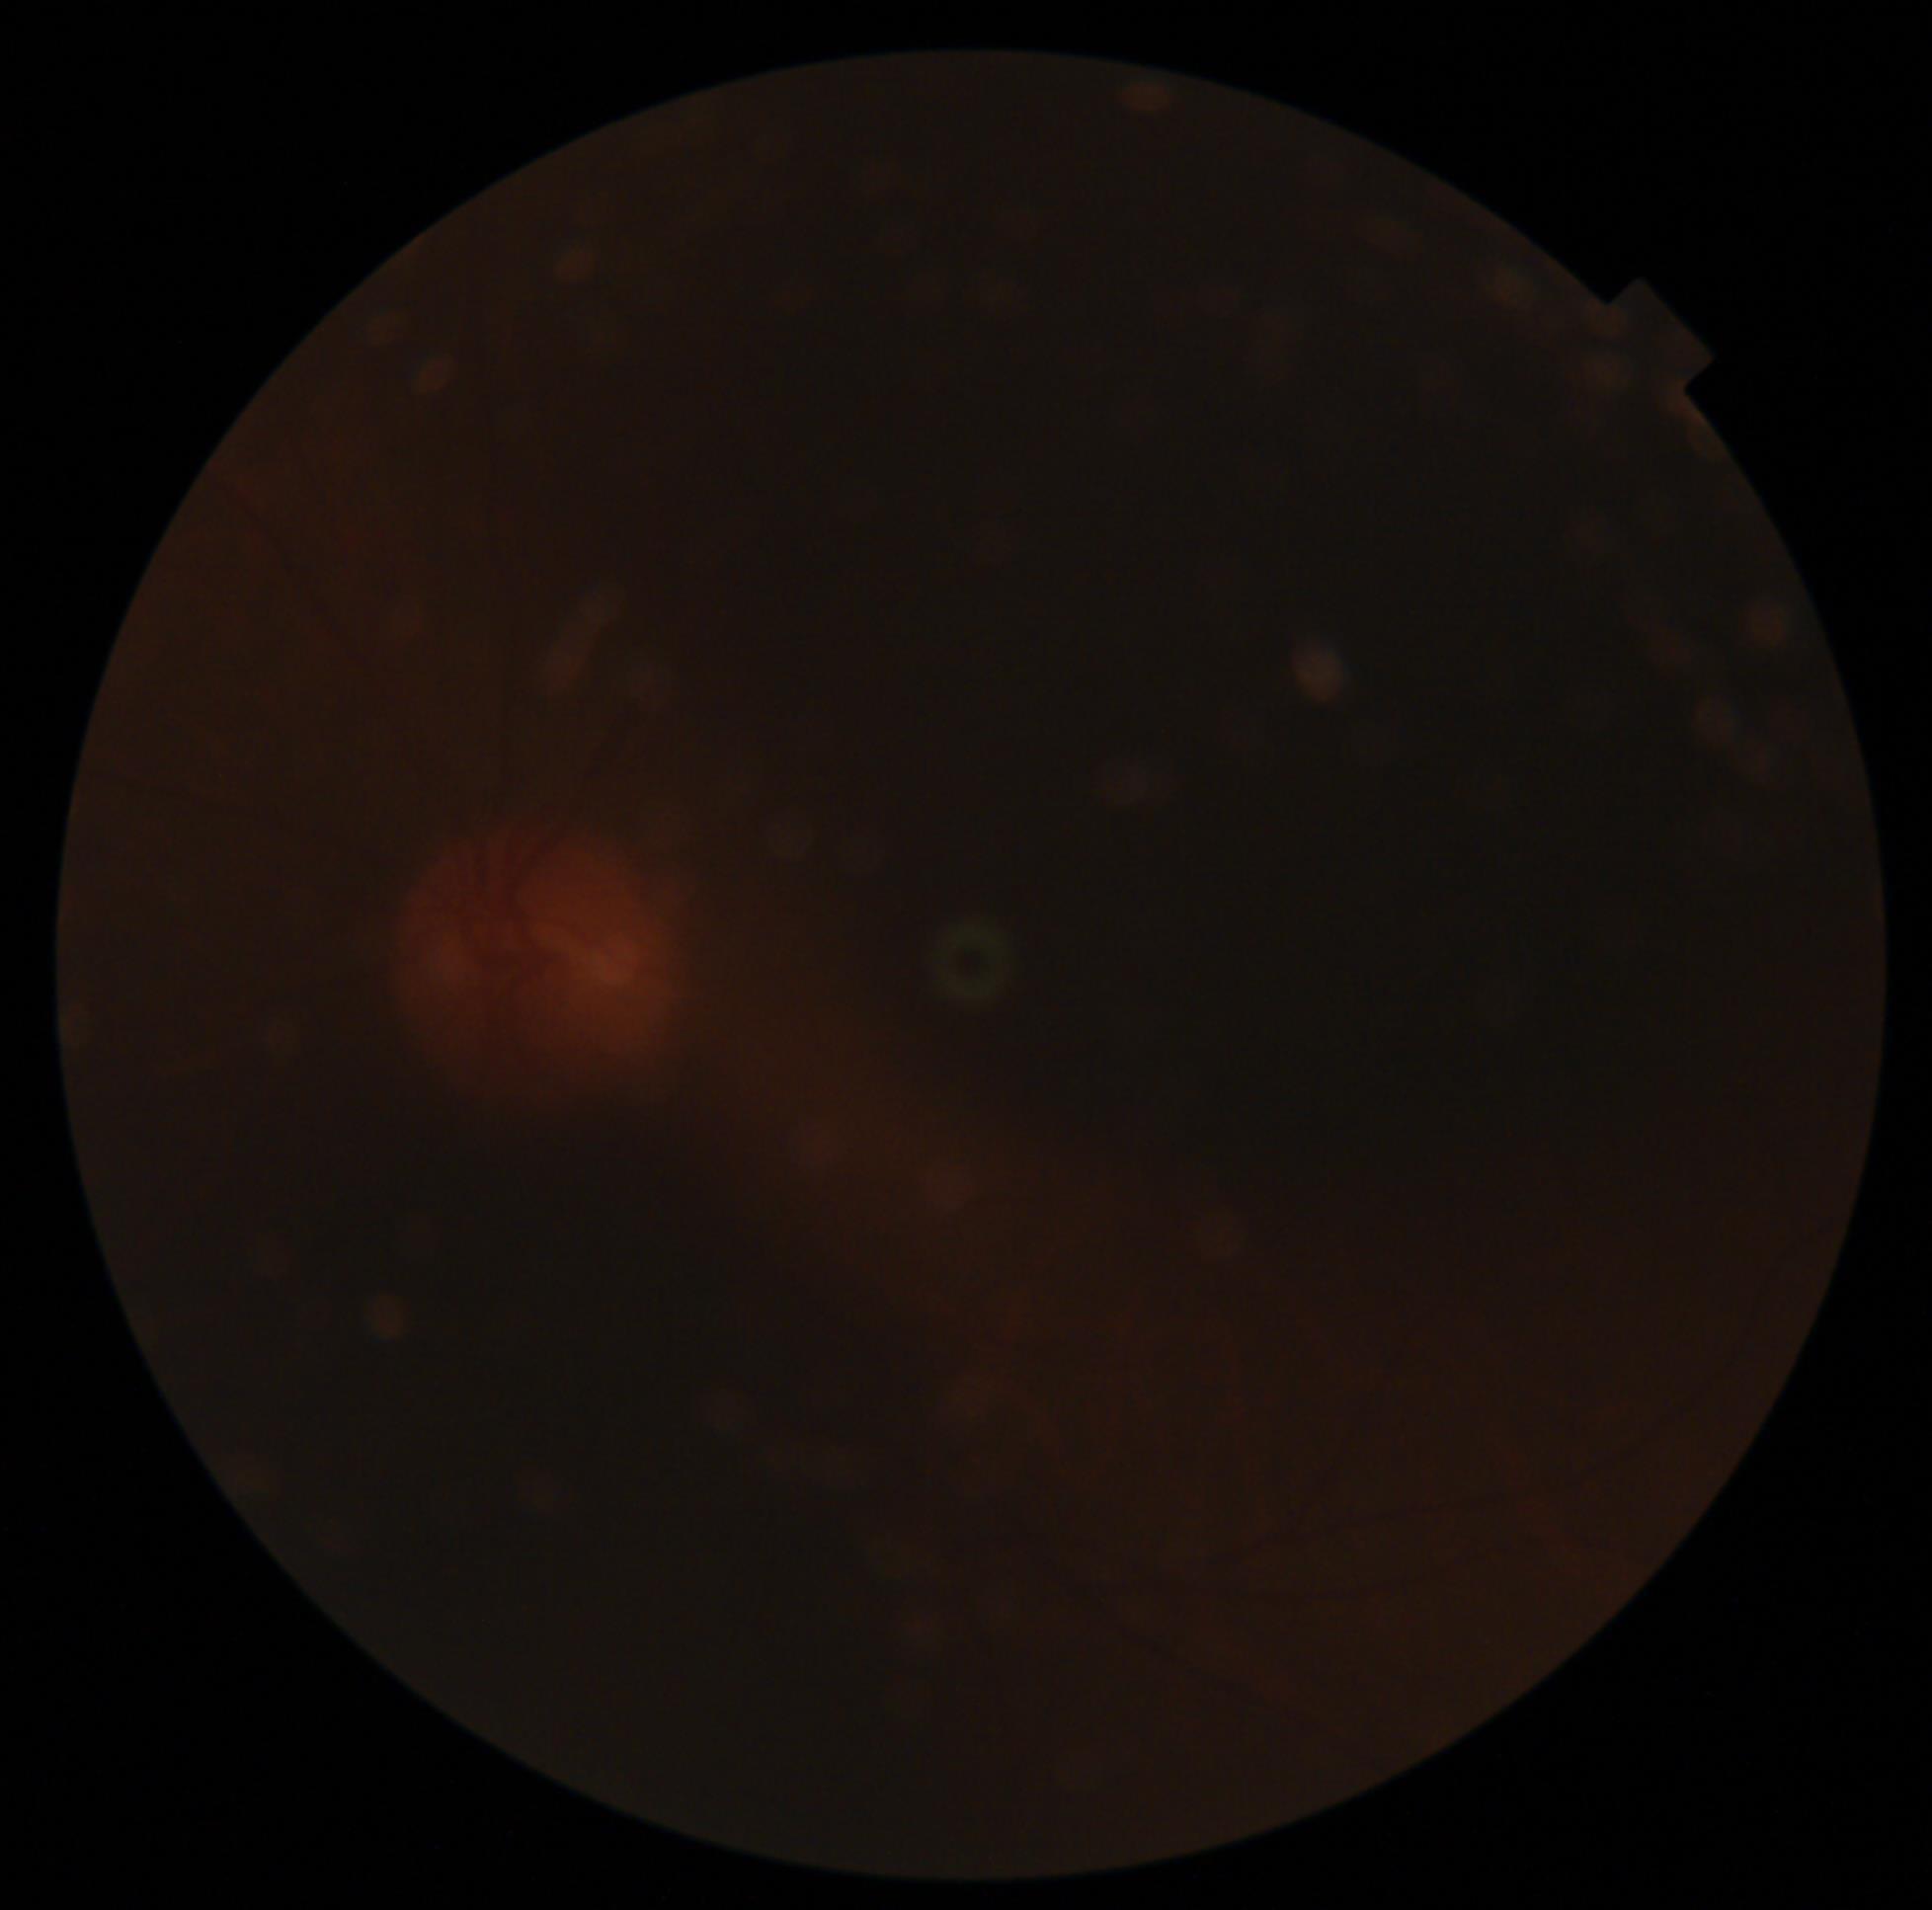
- image quality: insufficient for DR assessment
- diabetic retinopathy (DR): ungradable due to poor image quality